Posterior pole field covering the optic disc and macula:
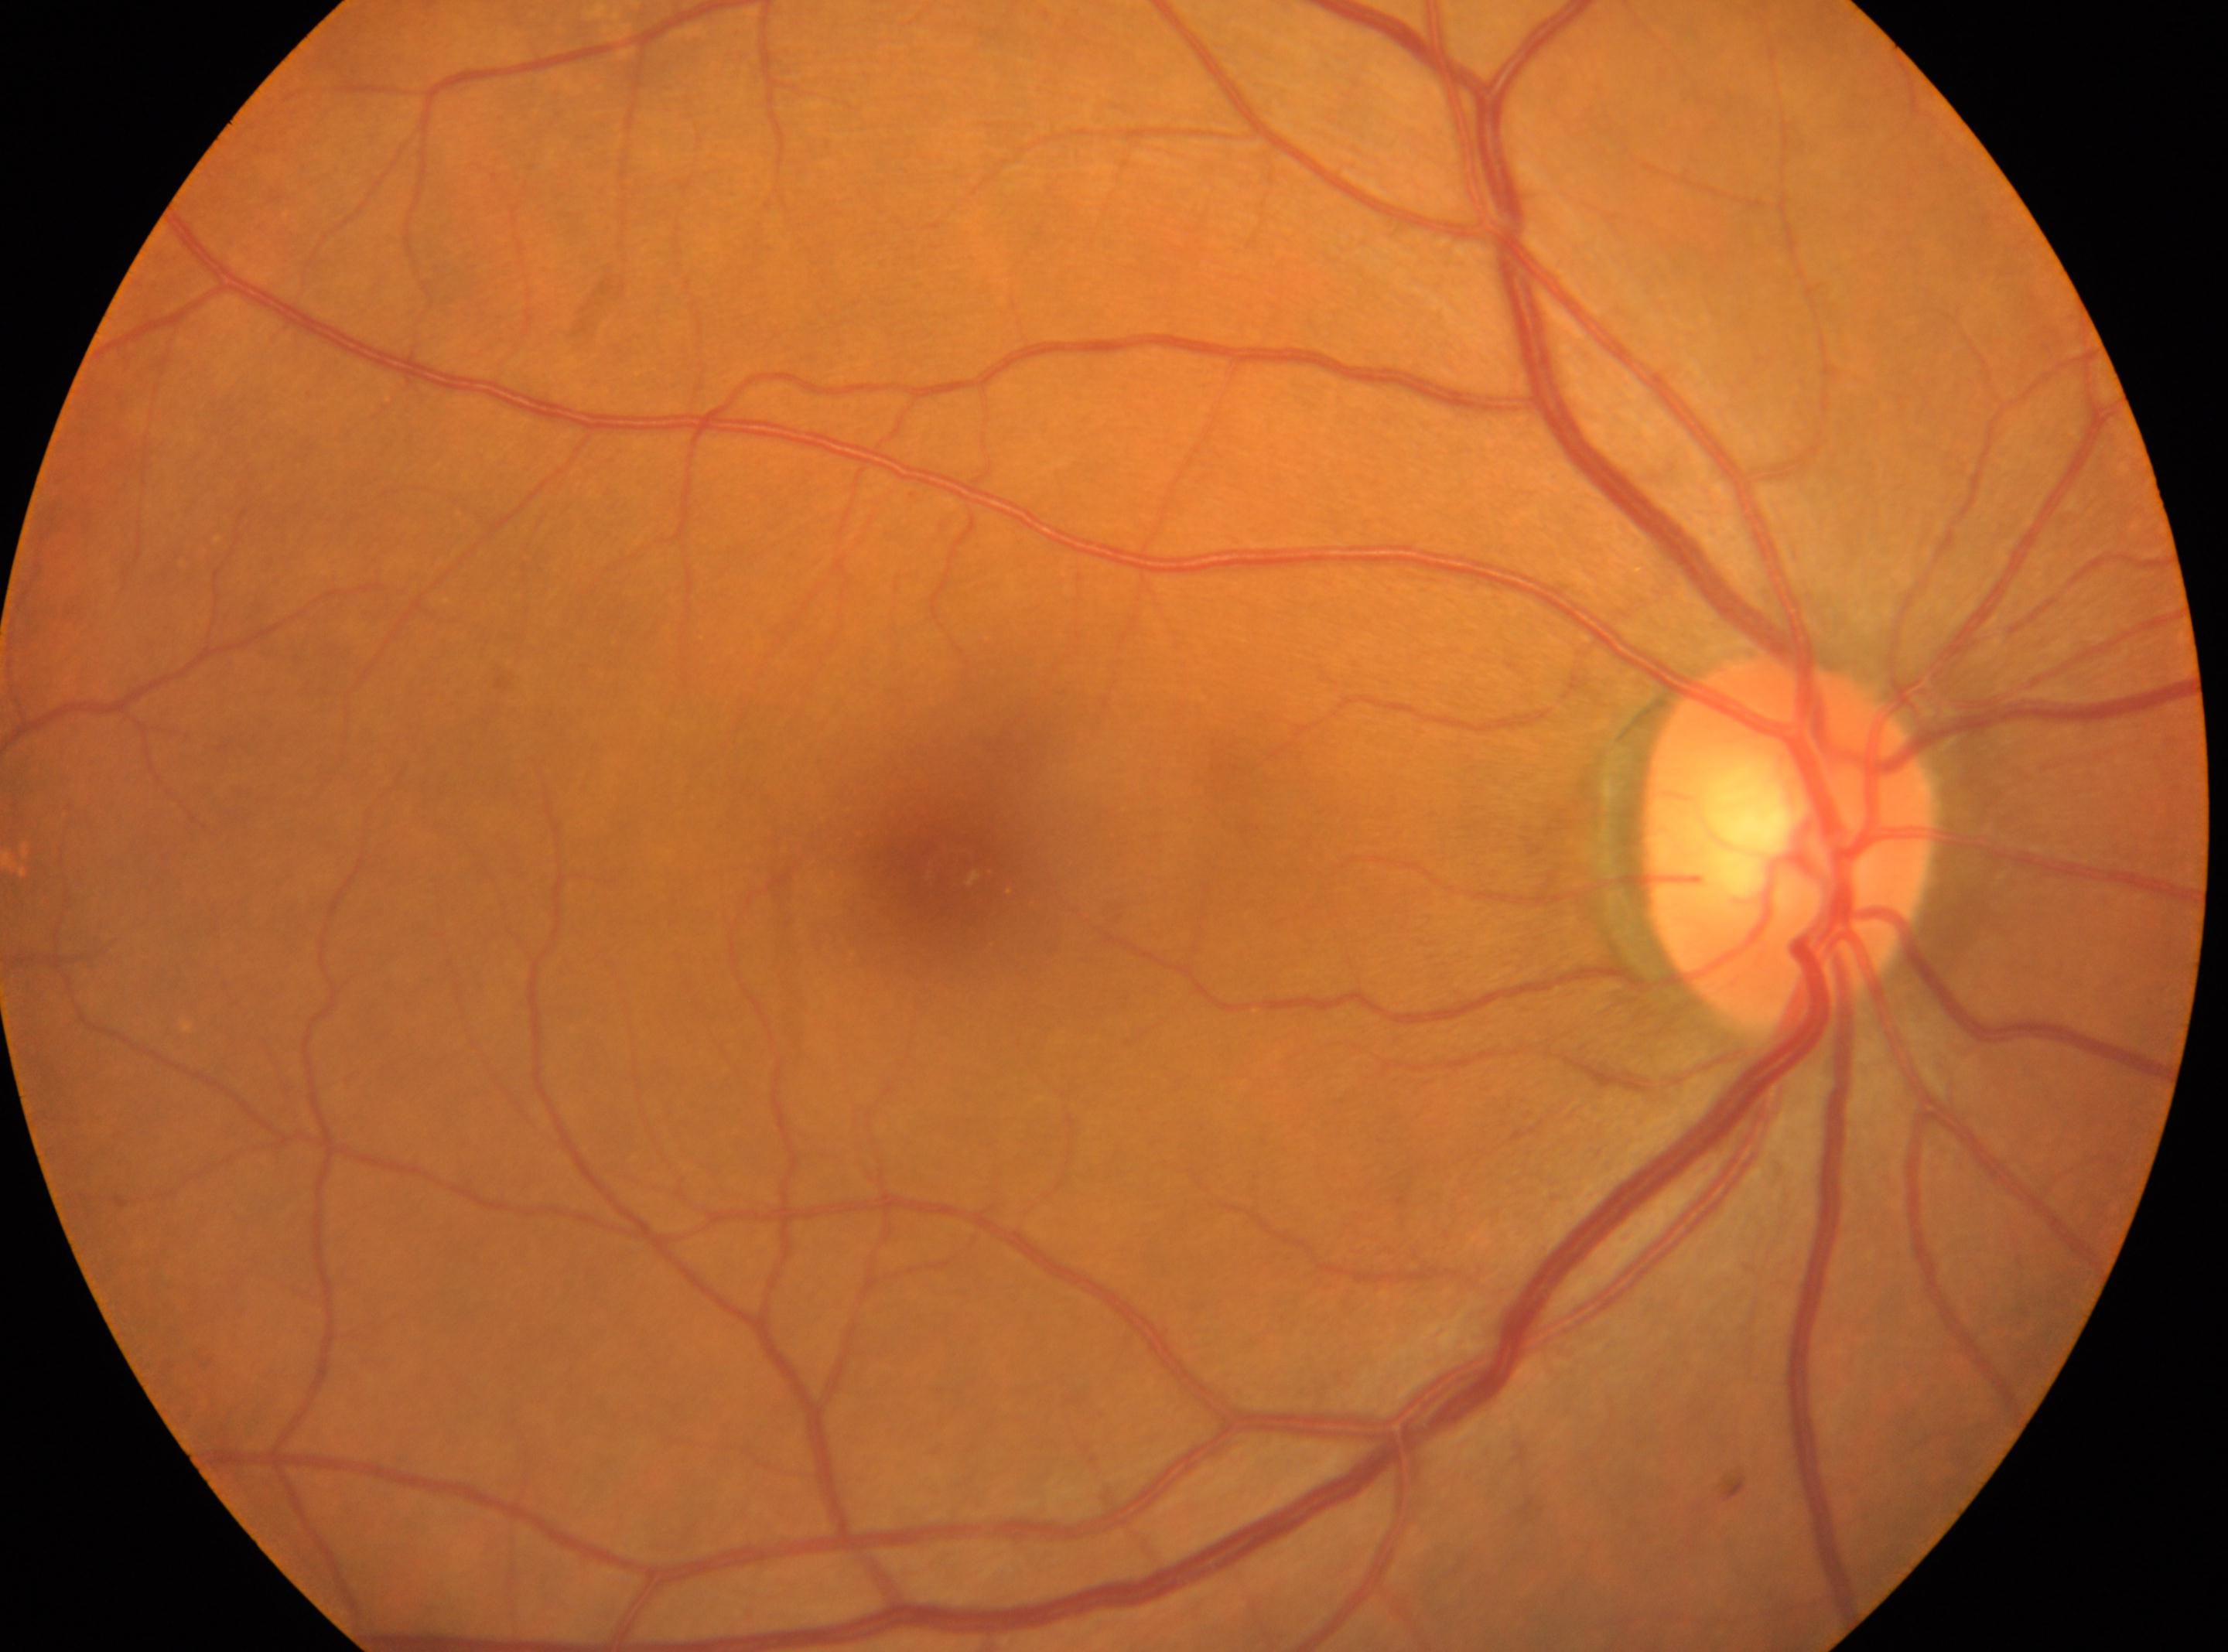 Findings:
* ONH: (x: 1787, y: 845)
* fovea centralis: (x: 950, y: 869)
* laterality: oculus dexter
* DR: no apparent diabetic retinopathy (grade 0)